2352x1568px. 45° FOV: 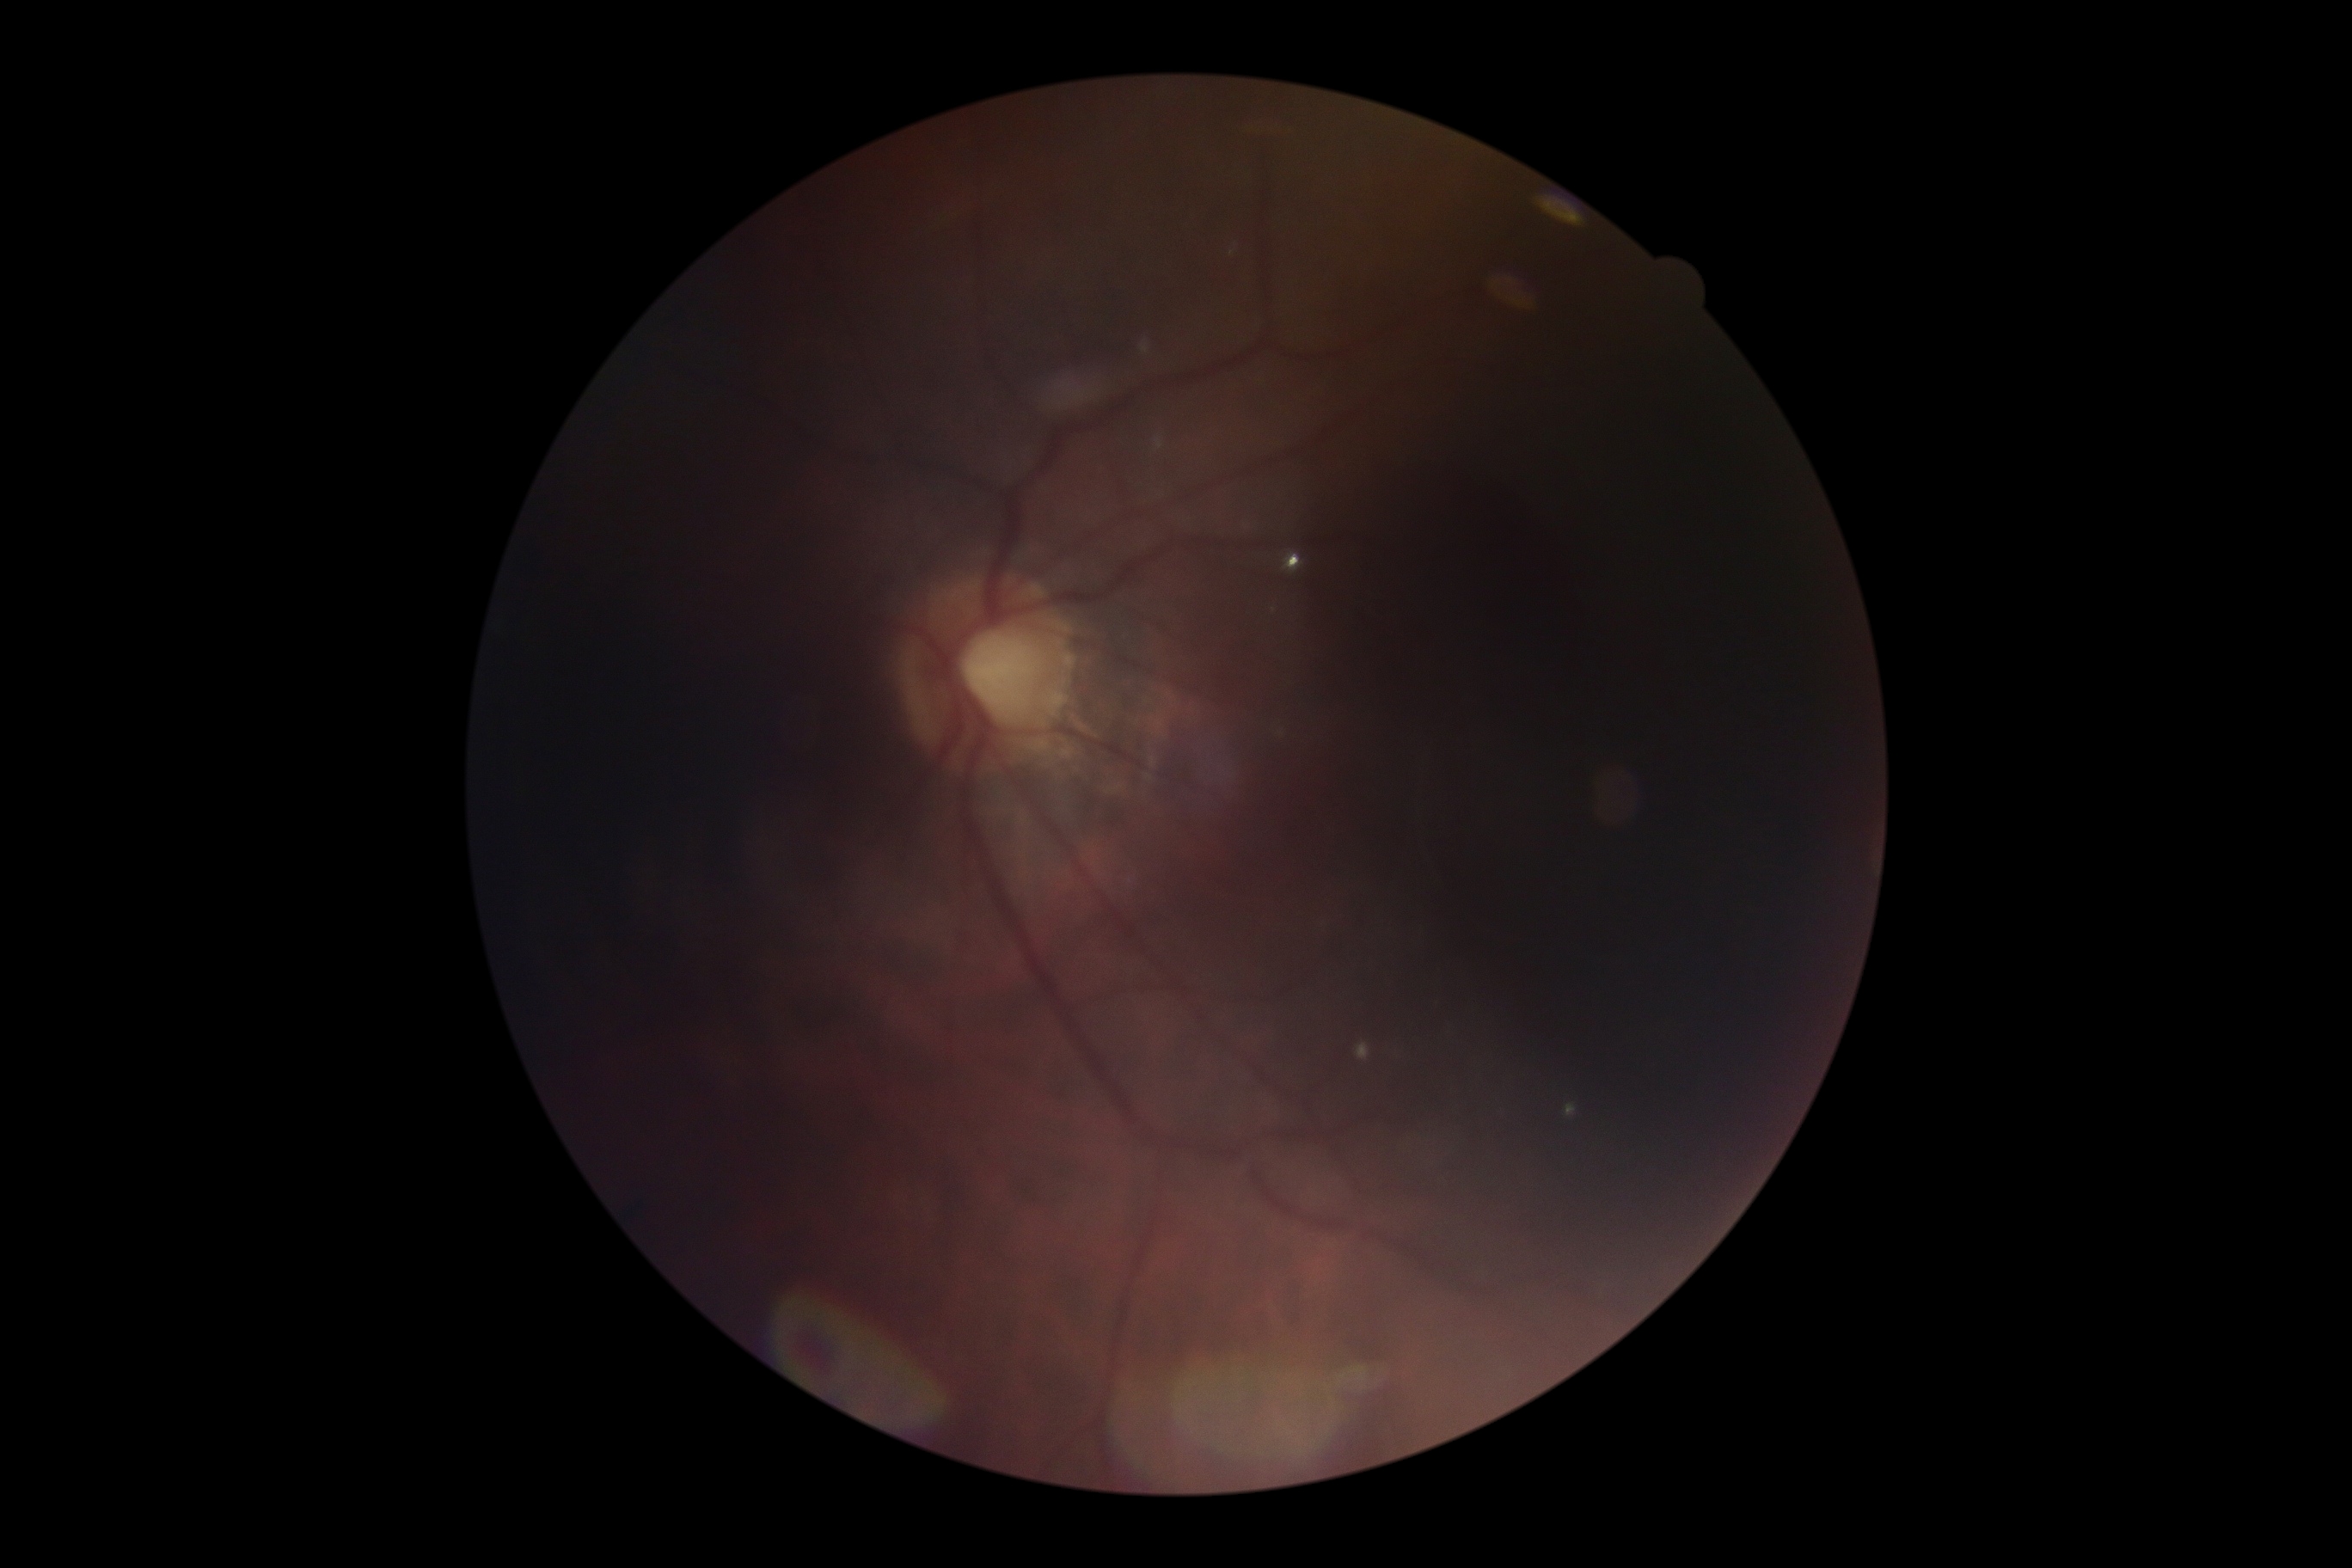
DR is ungradable due to poor image quality.